Wide-field fundus photograph of an infant — 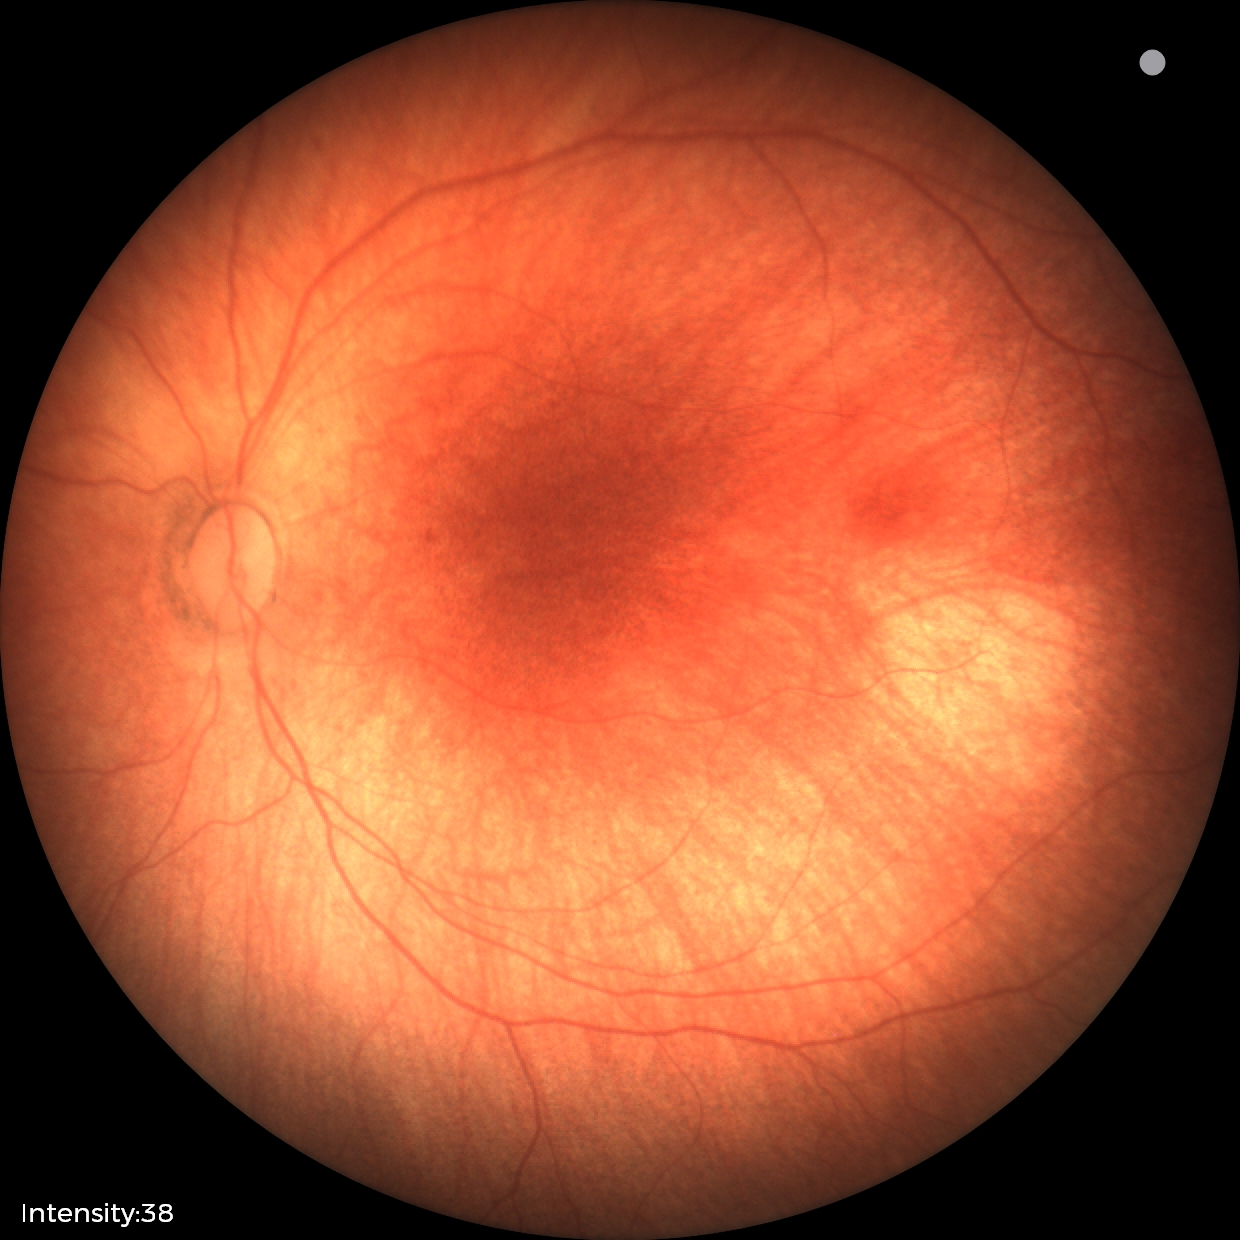 Q: What was the screening finding?
A: normal retinal appearance